Image size 2212x1659: 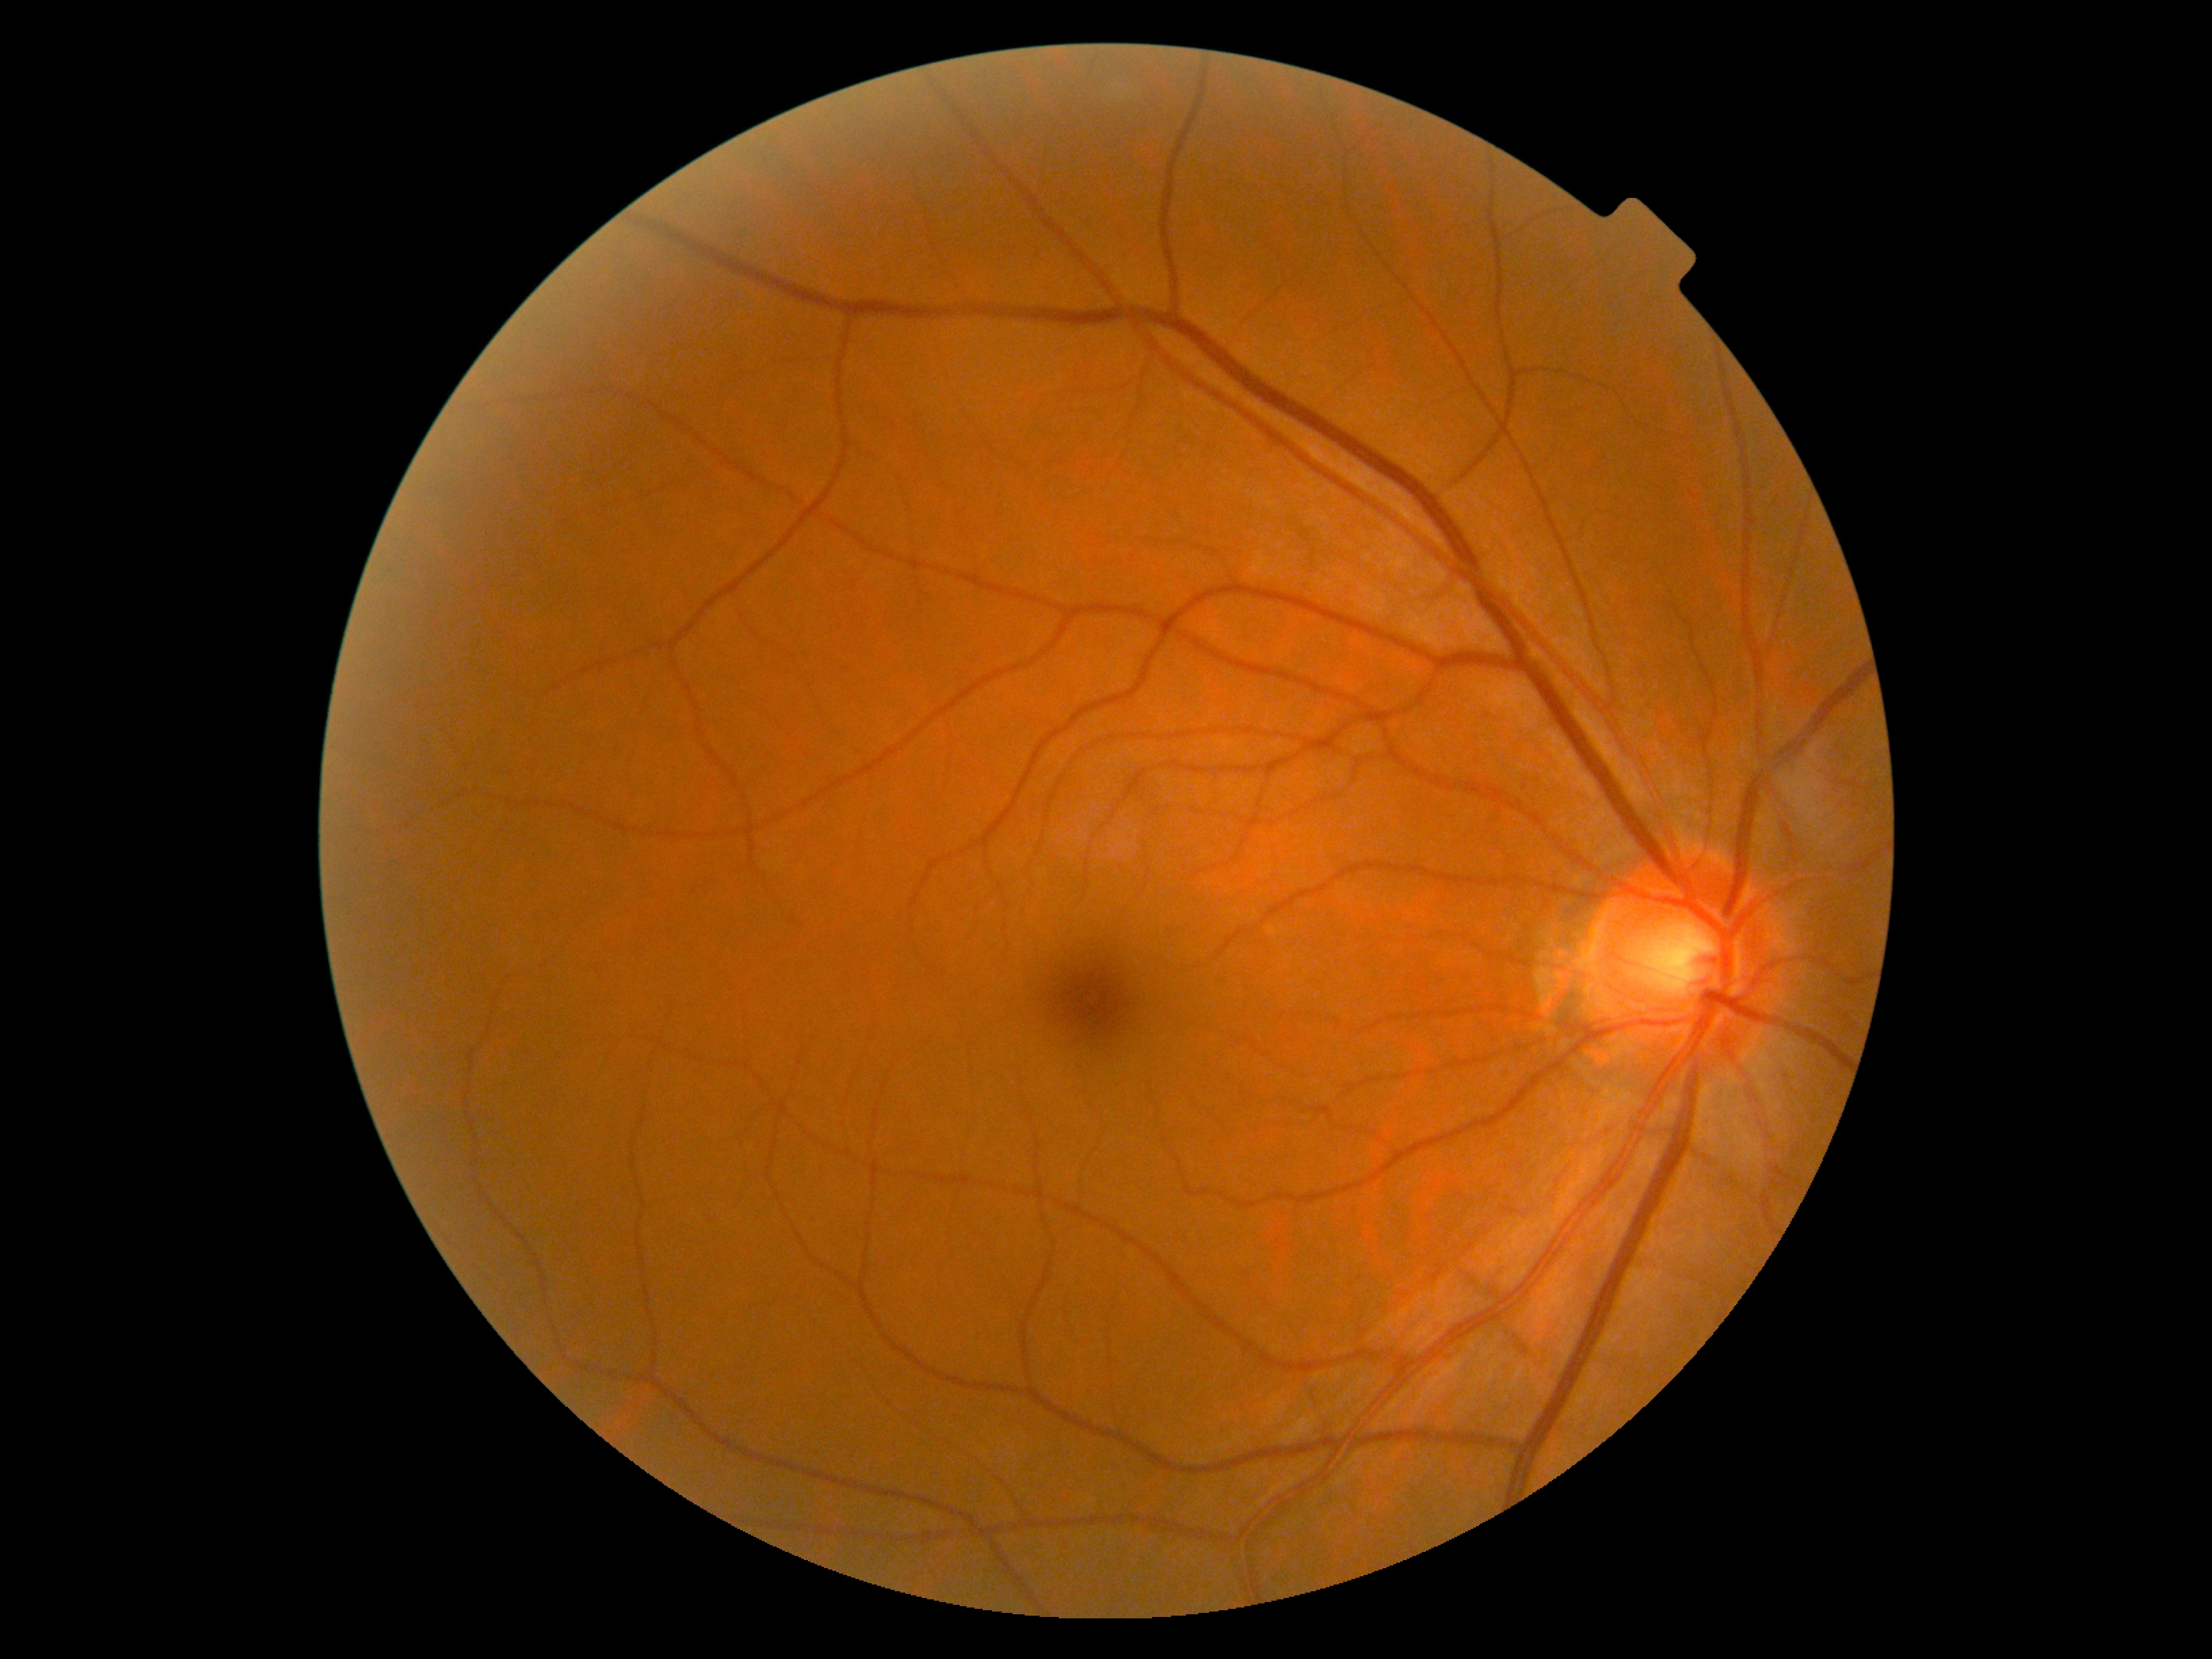
DR grade: 0/4 — no visible signs of diabetic retinopathy.